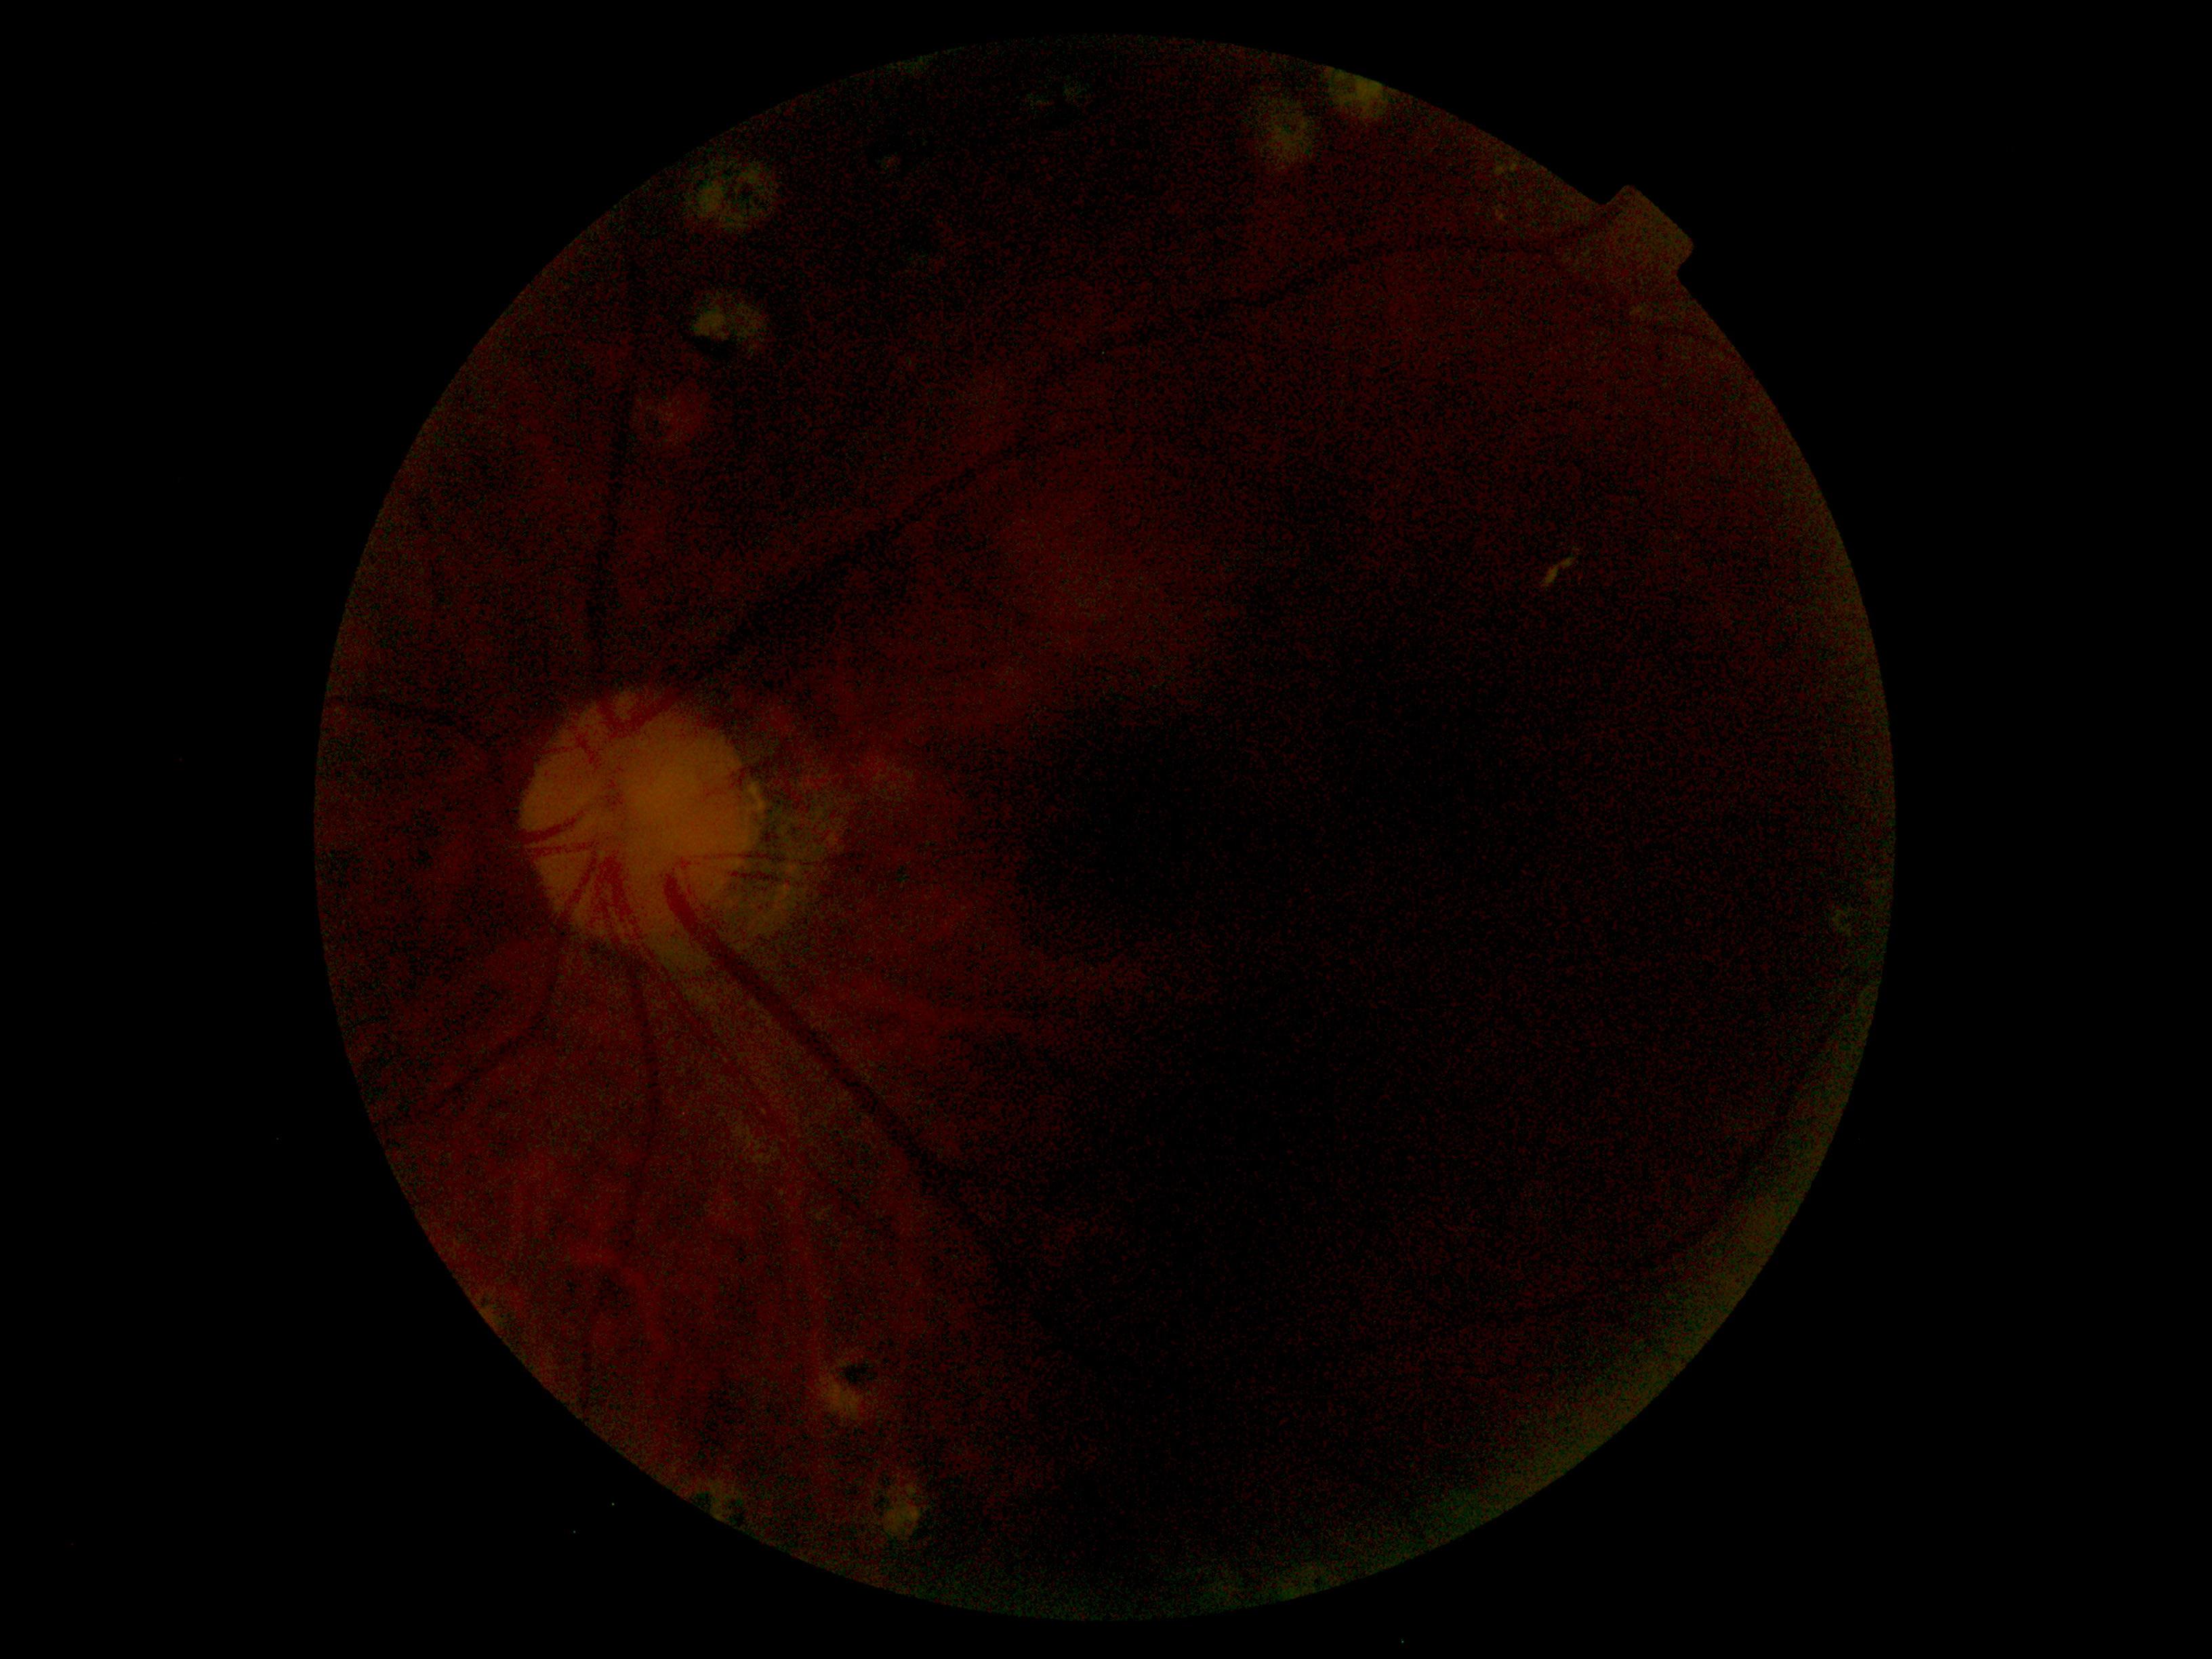

image quality: below grading threshold
DR severity: ungradable due to poor image quality